Graded on the modified Davis scale — 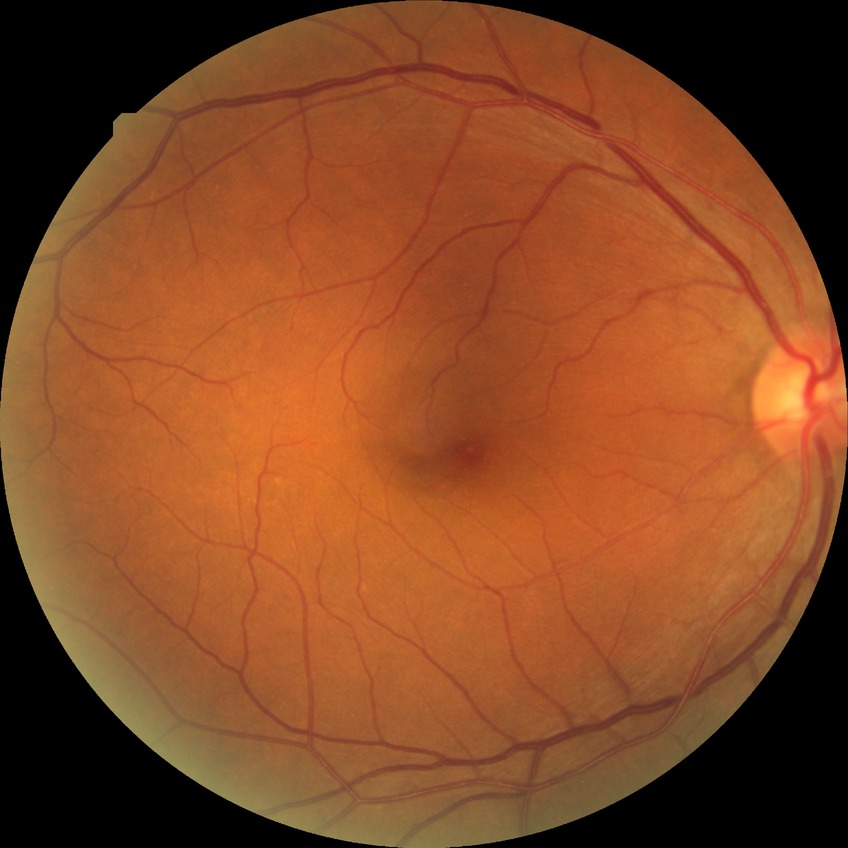

Davis DR grade: NDR.